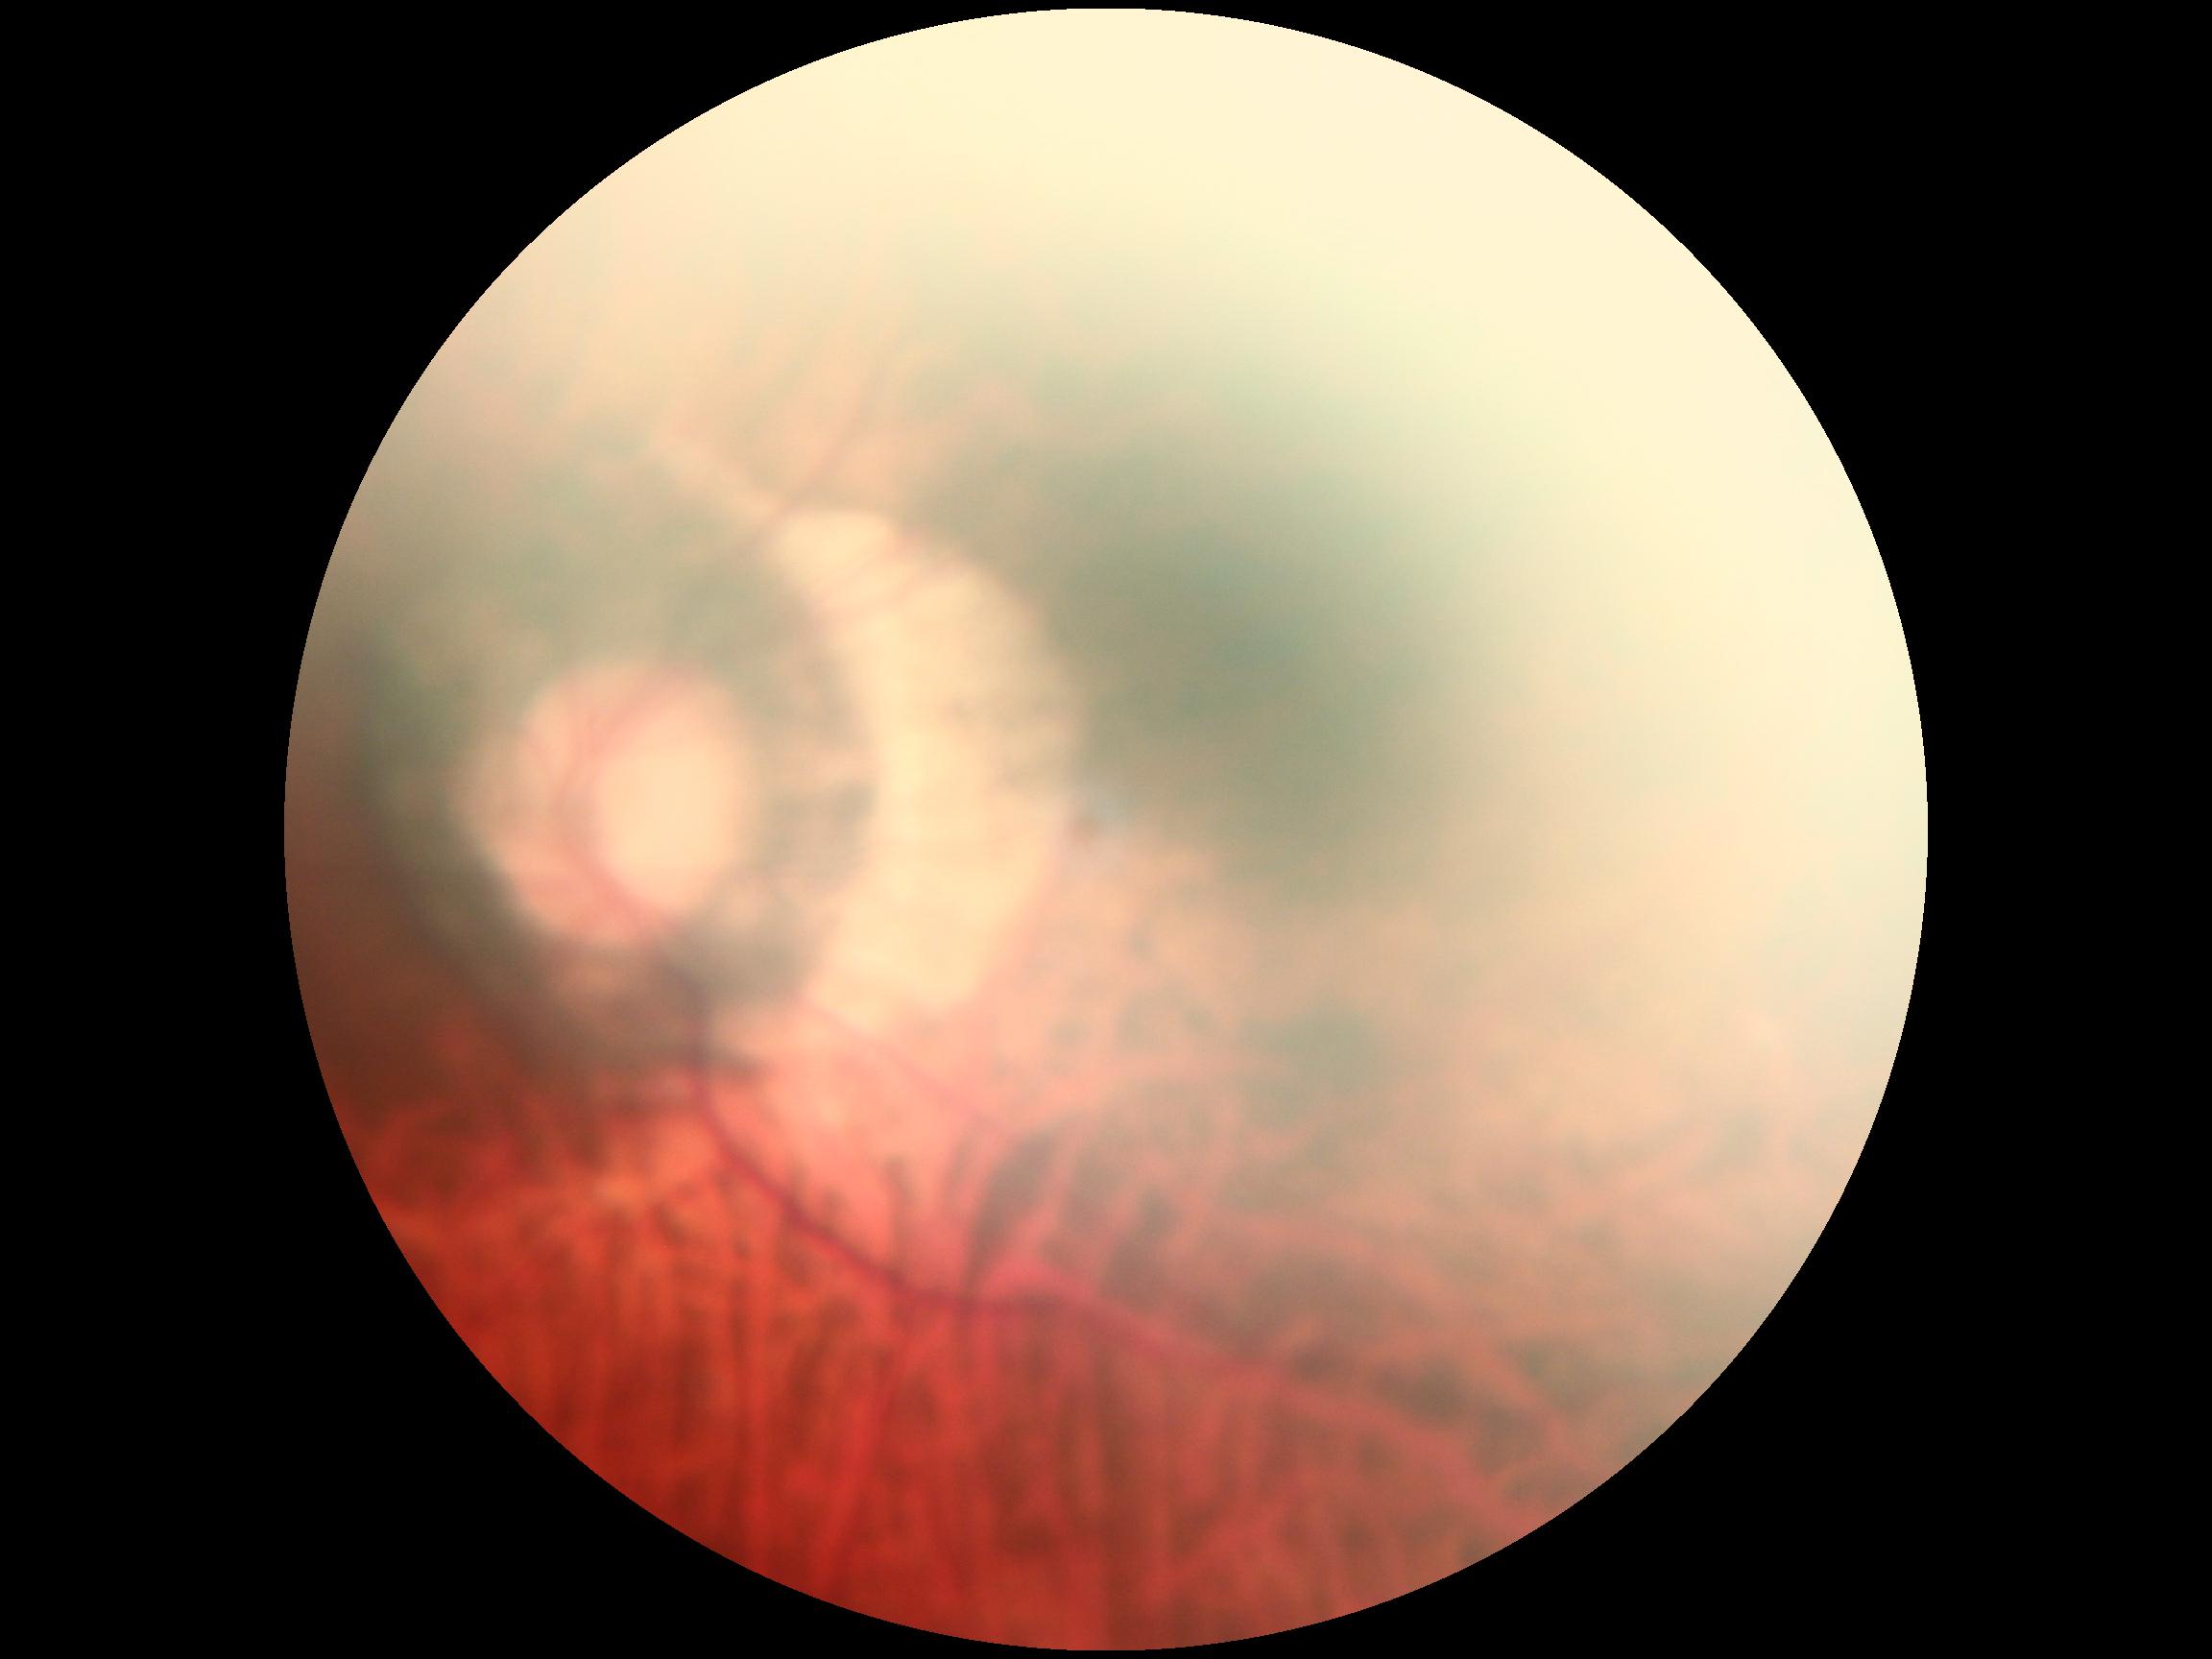

diabetic retinopathy grade = 0/4 | DR impression = no signs of DR.